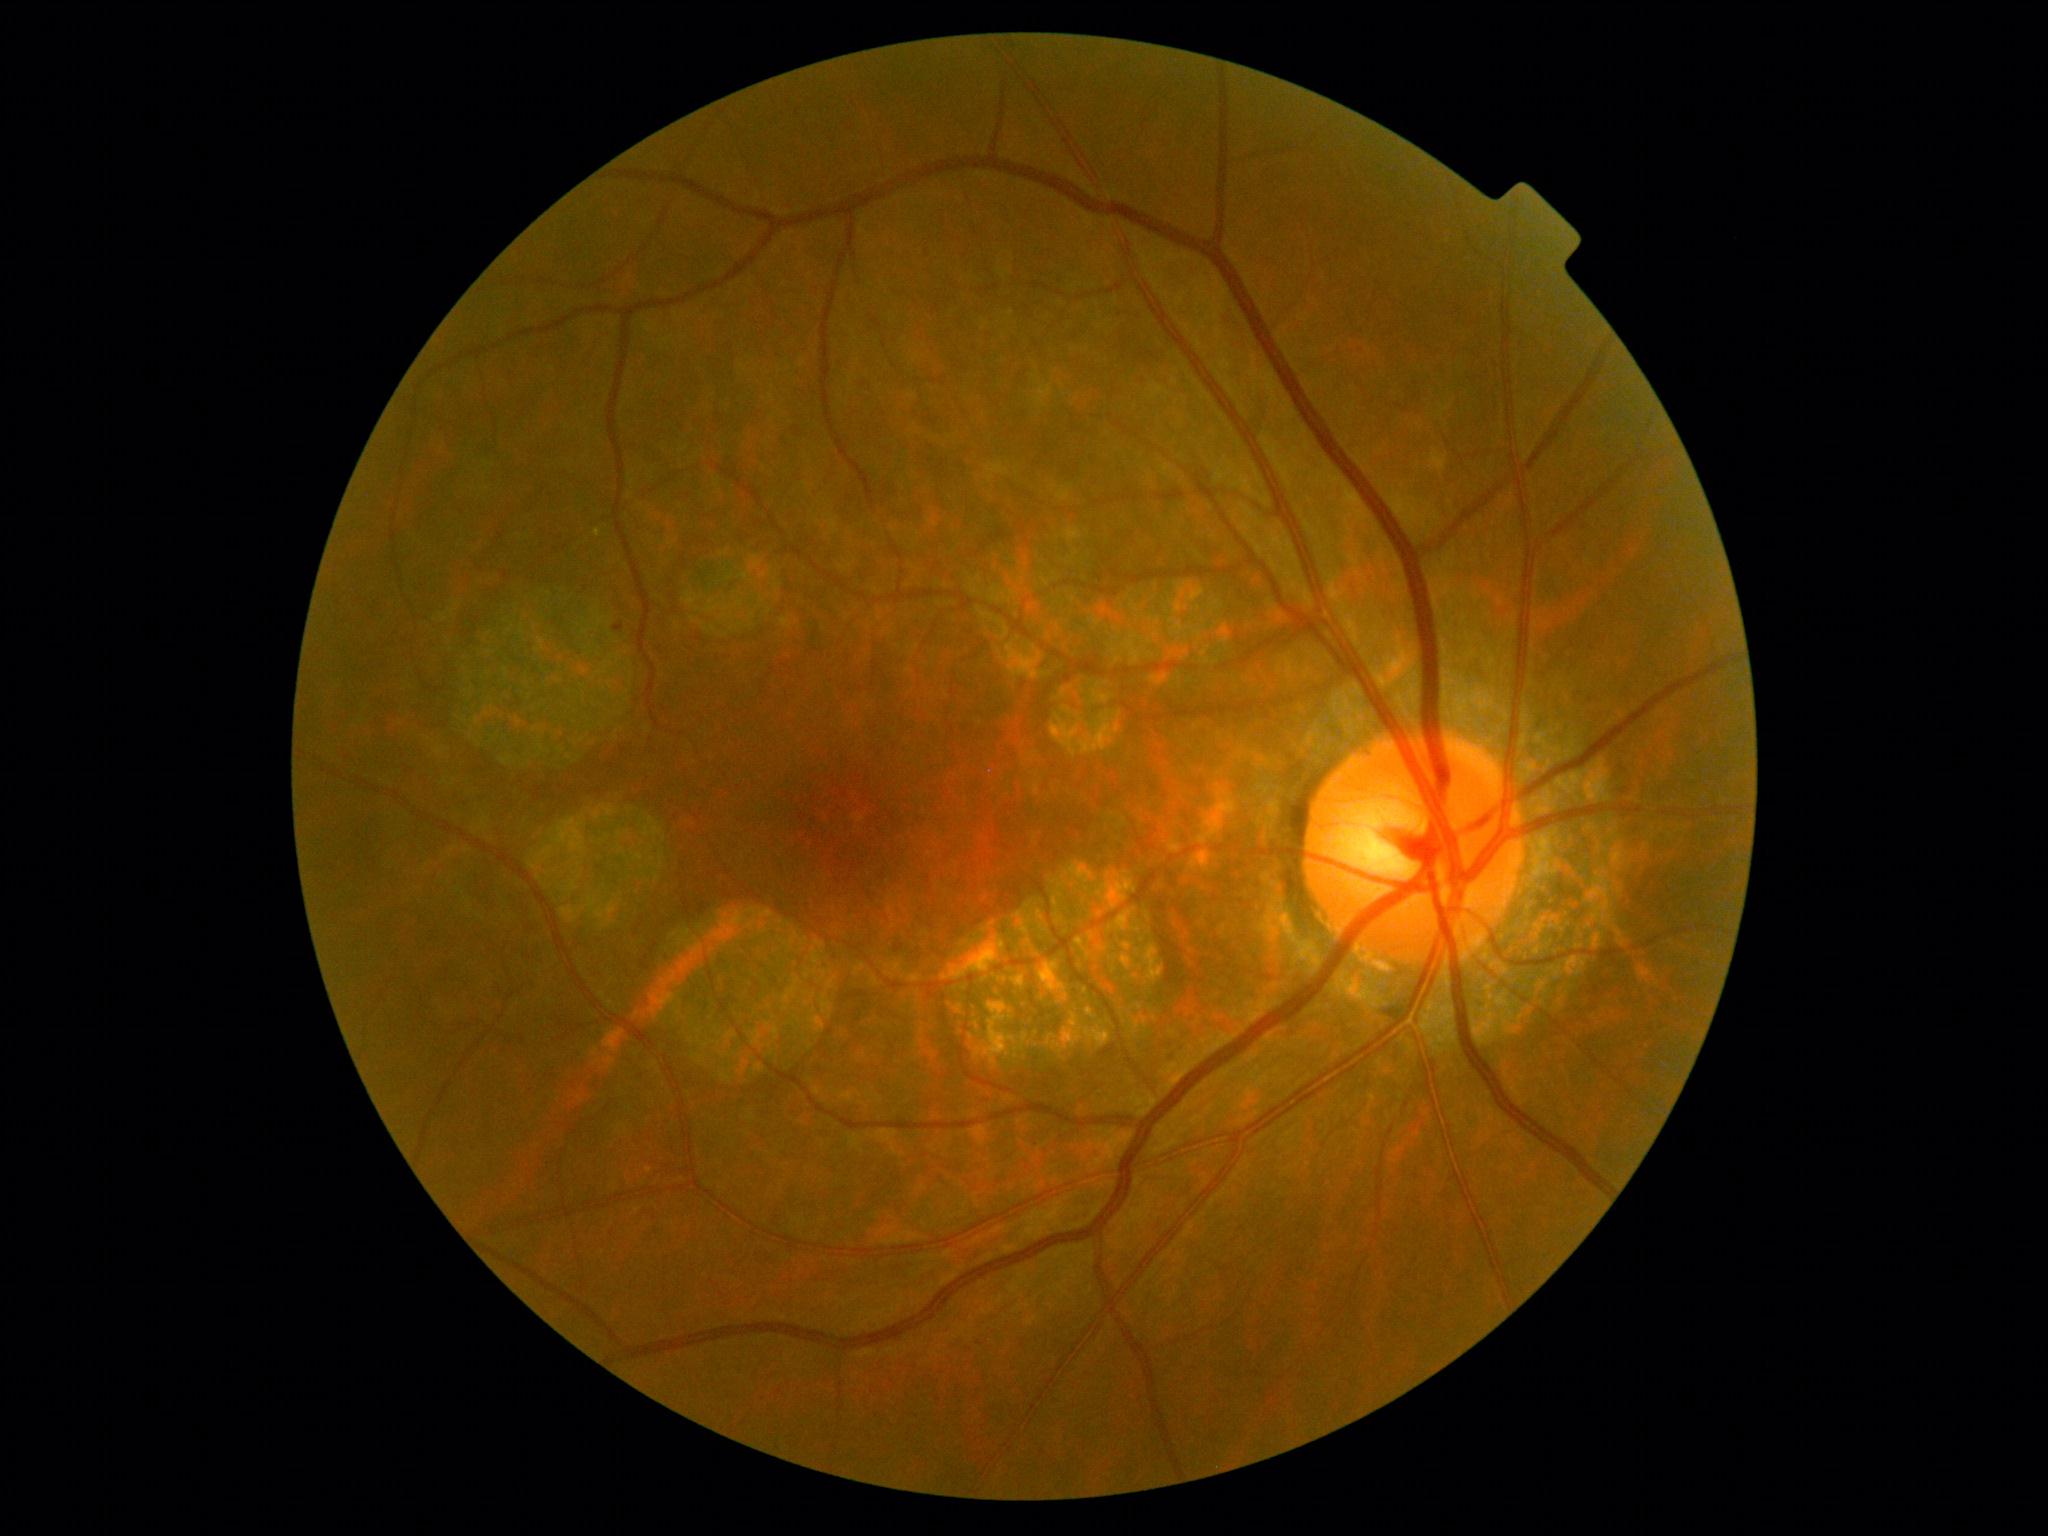 dr_grade: mild NPDR (1)